Retinal fundus photograph.
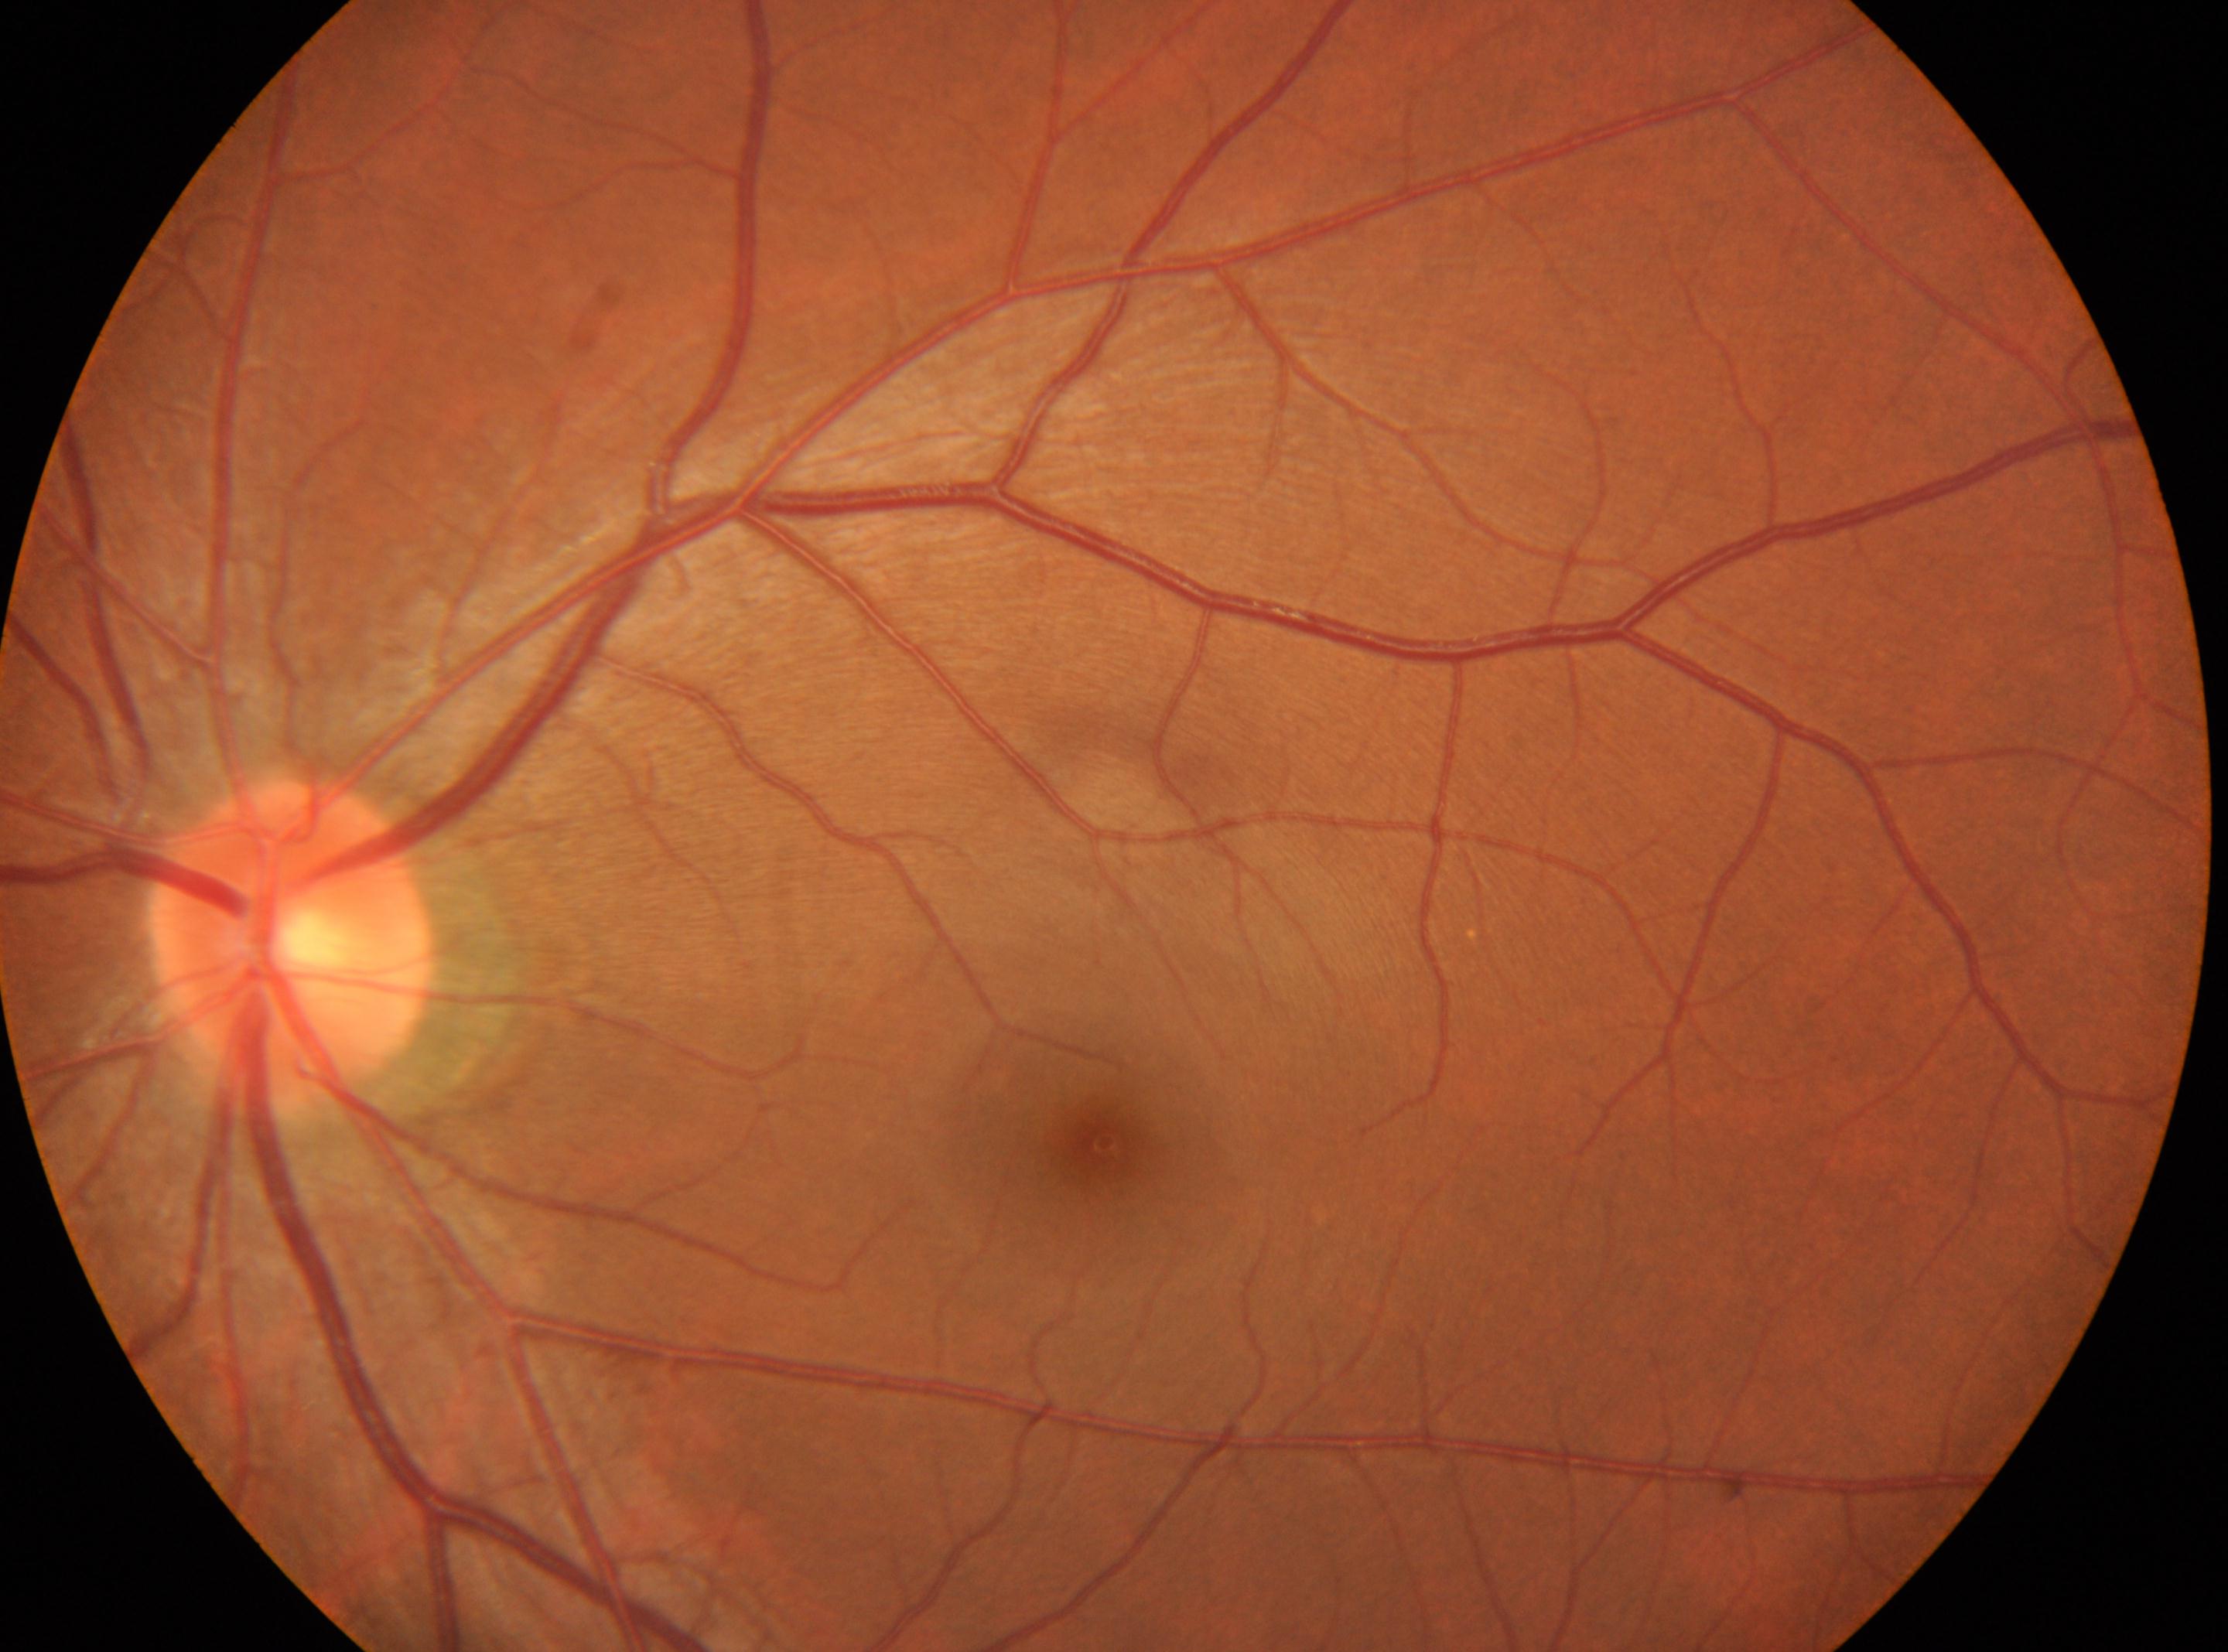
DR stage is grade 0. Macula center located at (1105,1142). Disc center located at (290,943). This is the left eye.